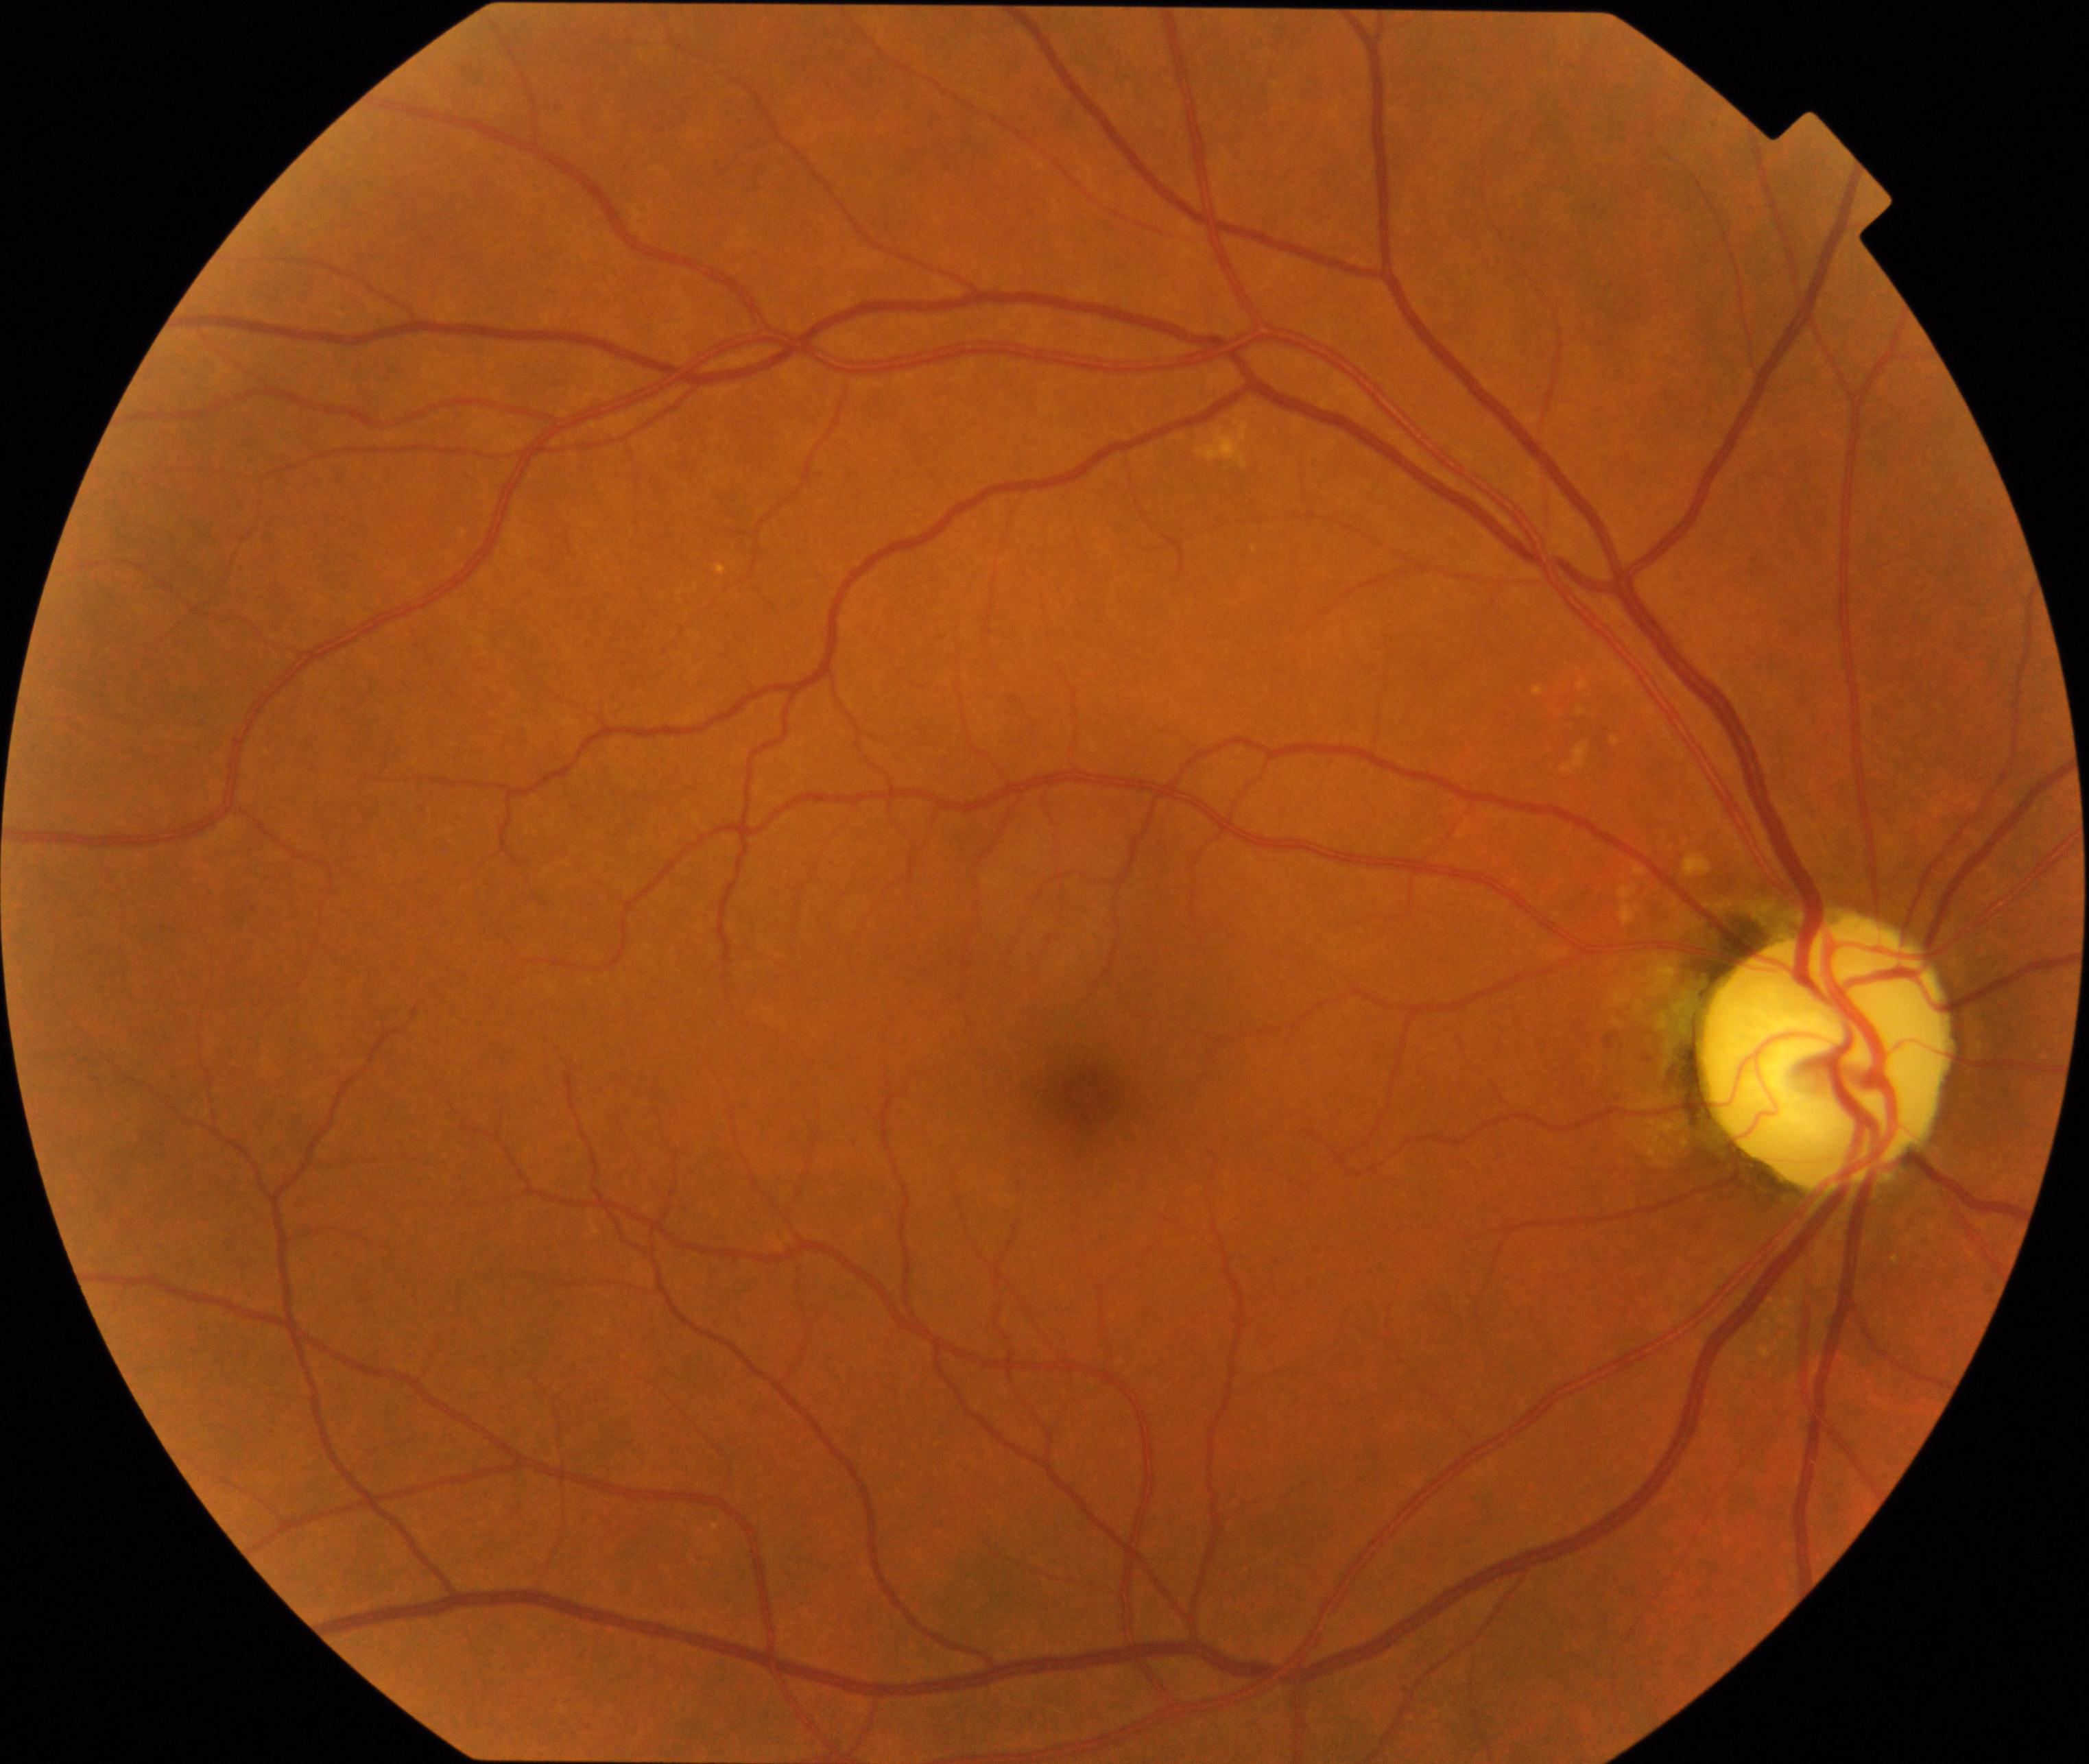
Fundus appearance consistent with optic atrophy. Defined by white optic disc with reduced small vessels on the disc, attenuation of peripapillary vessels, and thinning of the retinal nerve fiber layer, sometimes with Paton lines.